640x480px · infant wide-field retinal image: 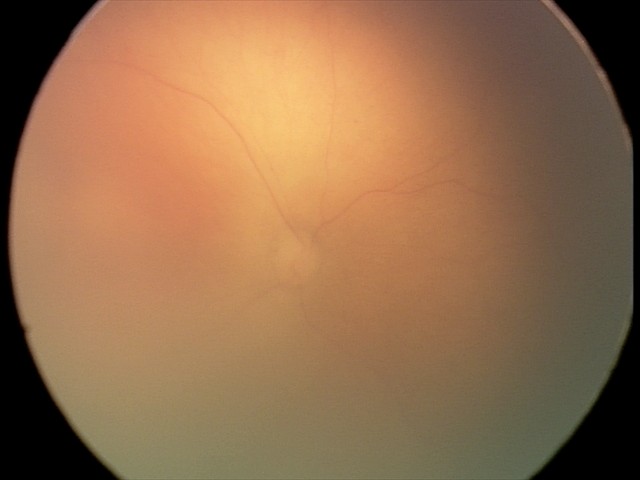 Screening series with retinopathy of prematurity stage 0.